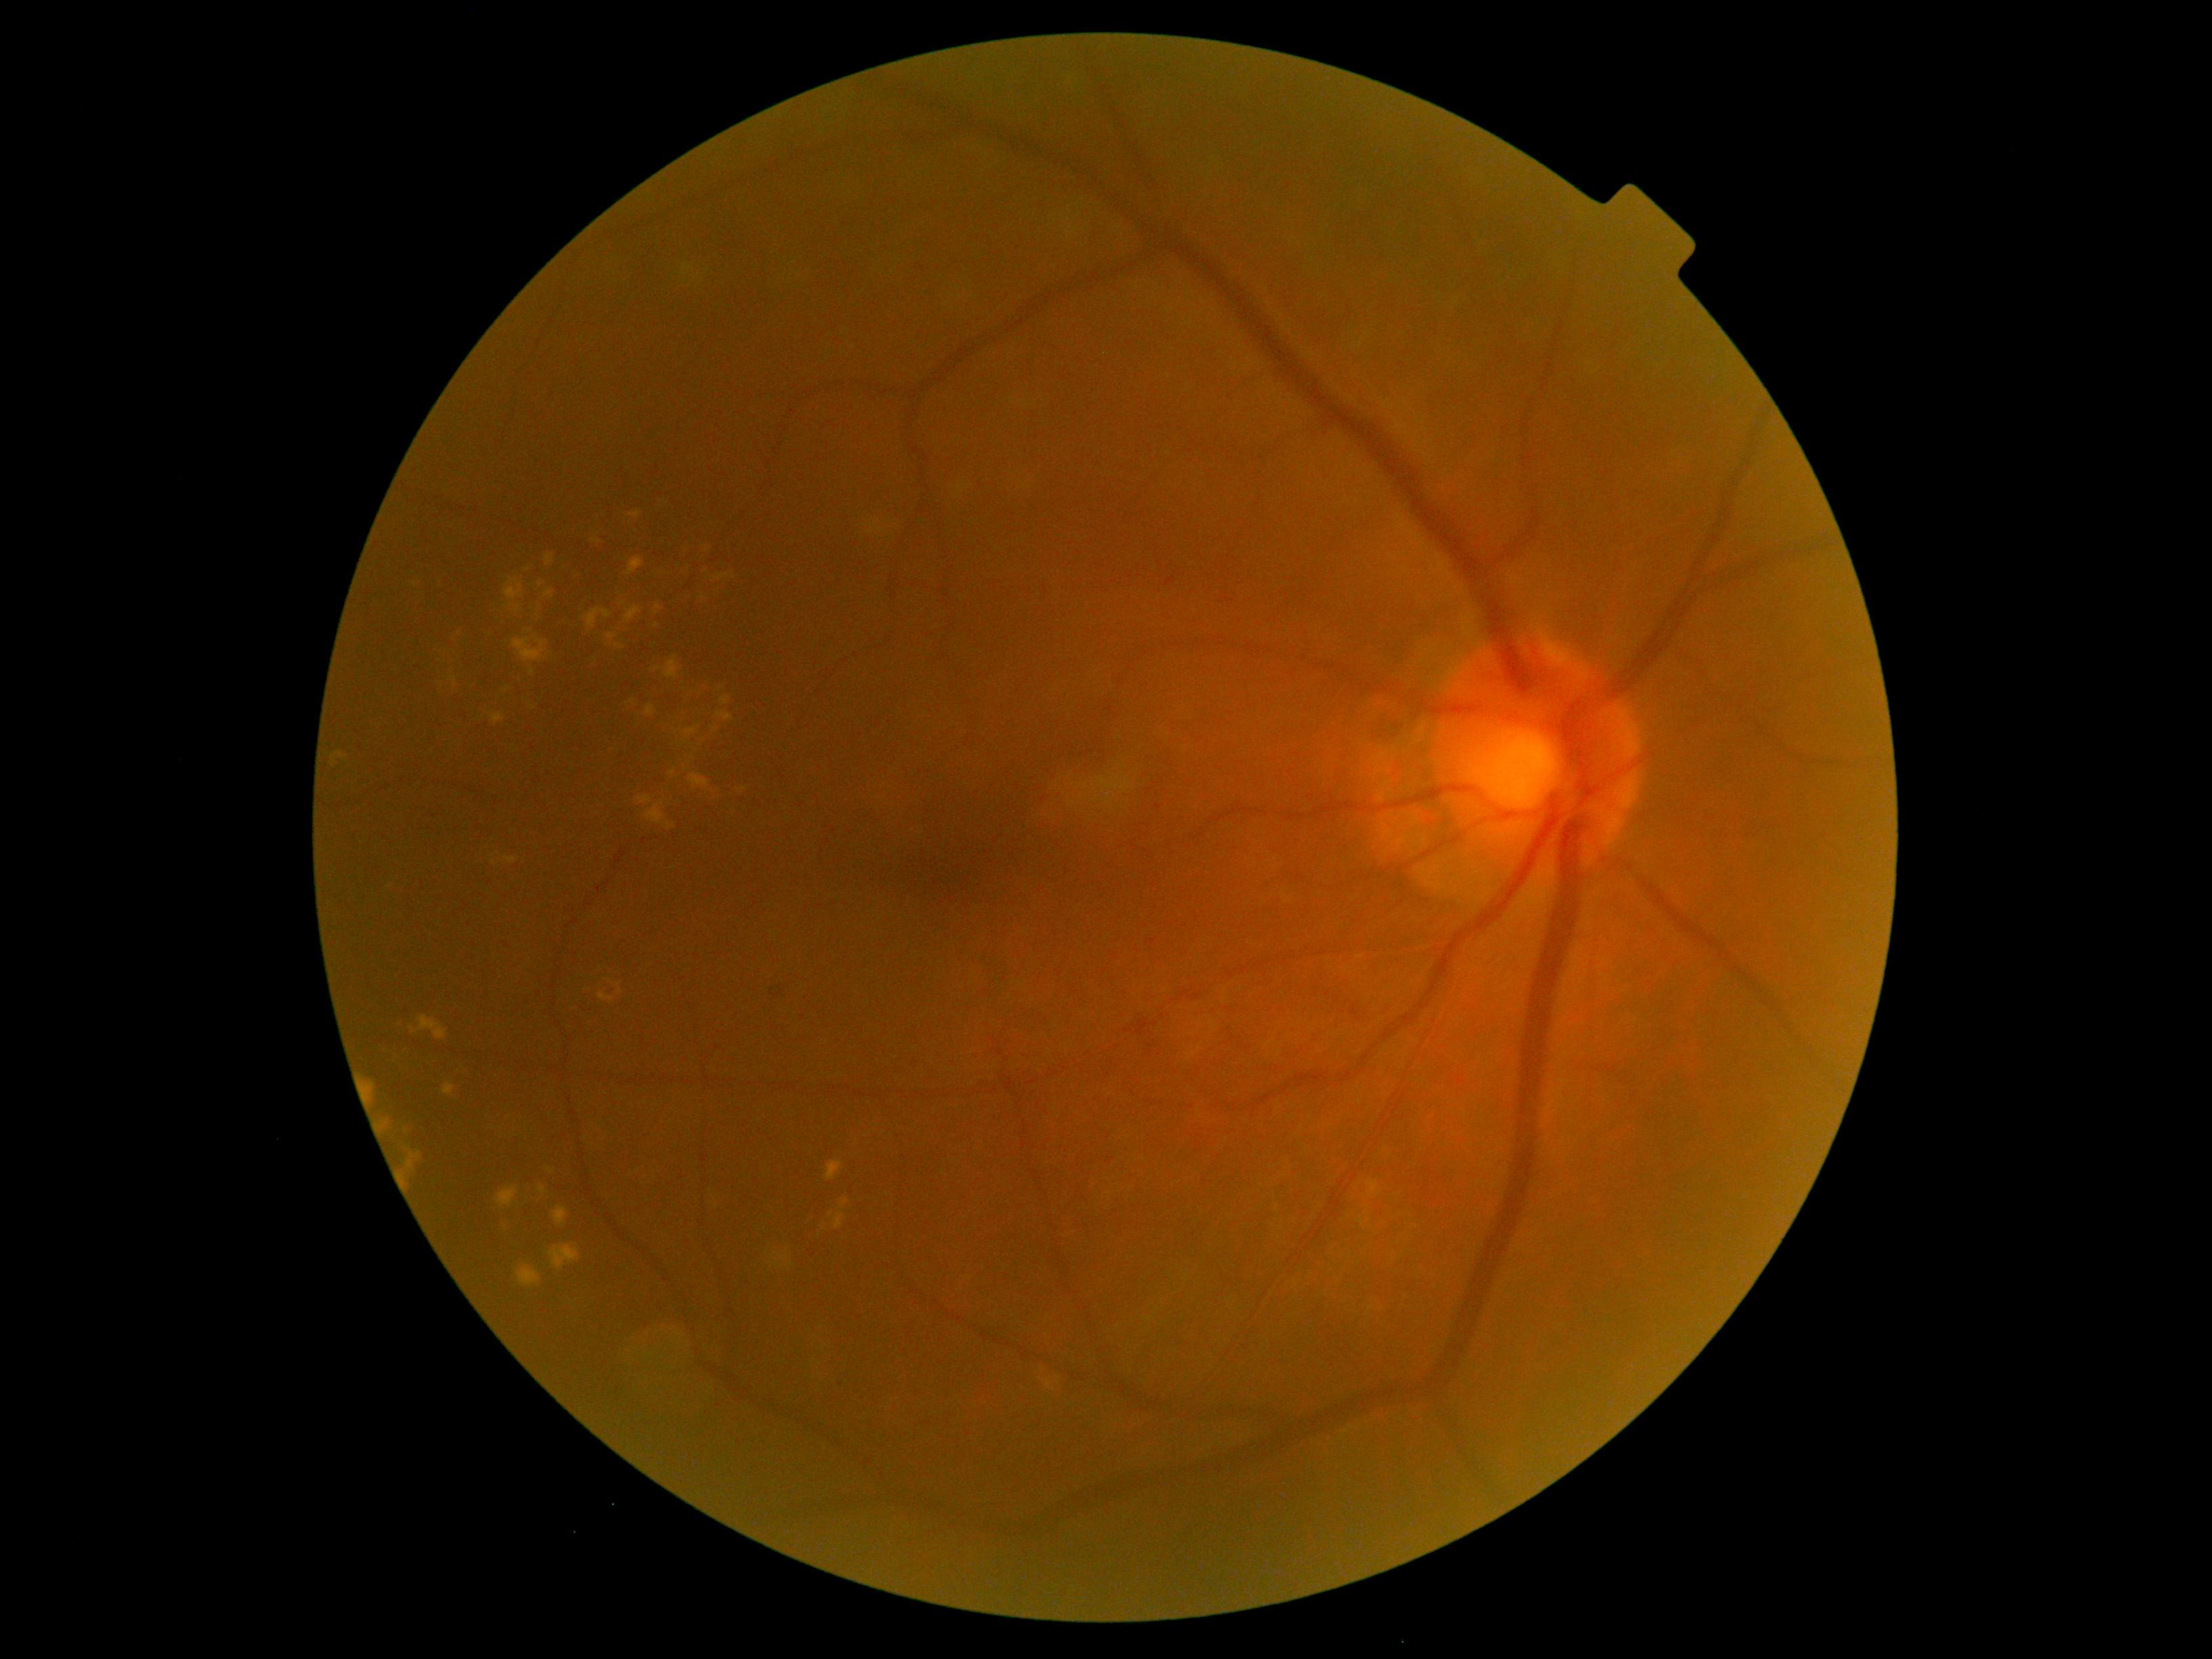 DR severity=2.